Modified Davis grading:
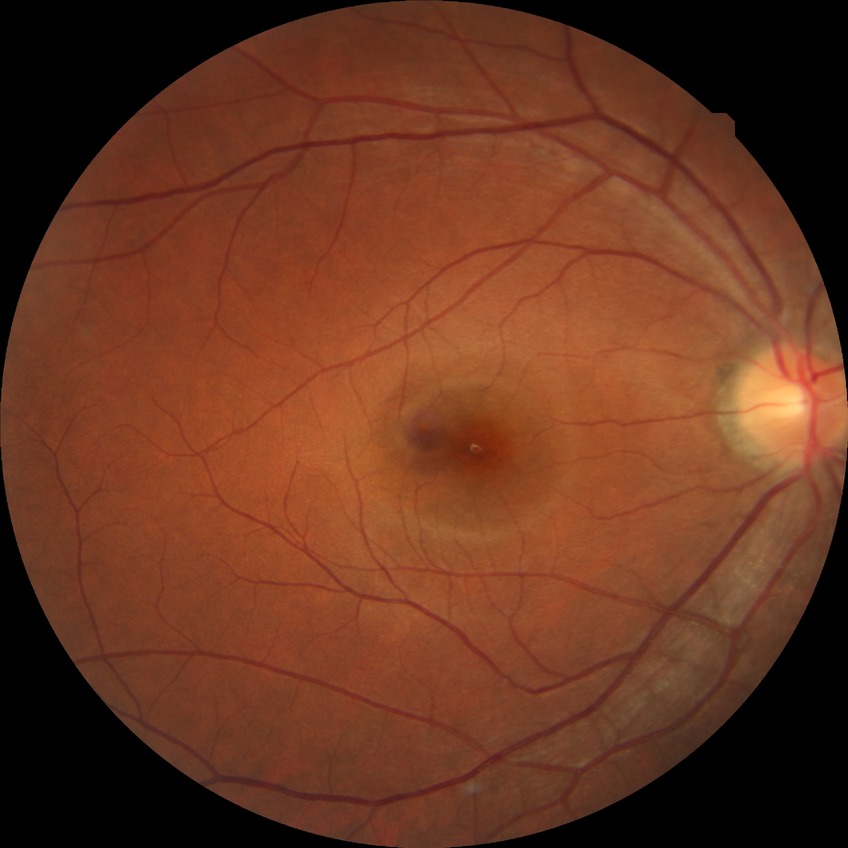

Diabetic retinopathy (DR): no diabetic retinopathy (NDR).